DR severity per modified Davis staging · NIDEK AFC-230 · 45° FOV: 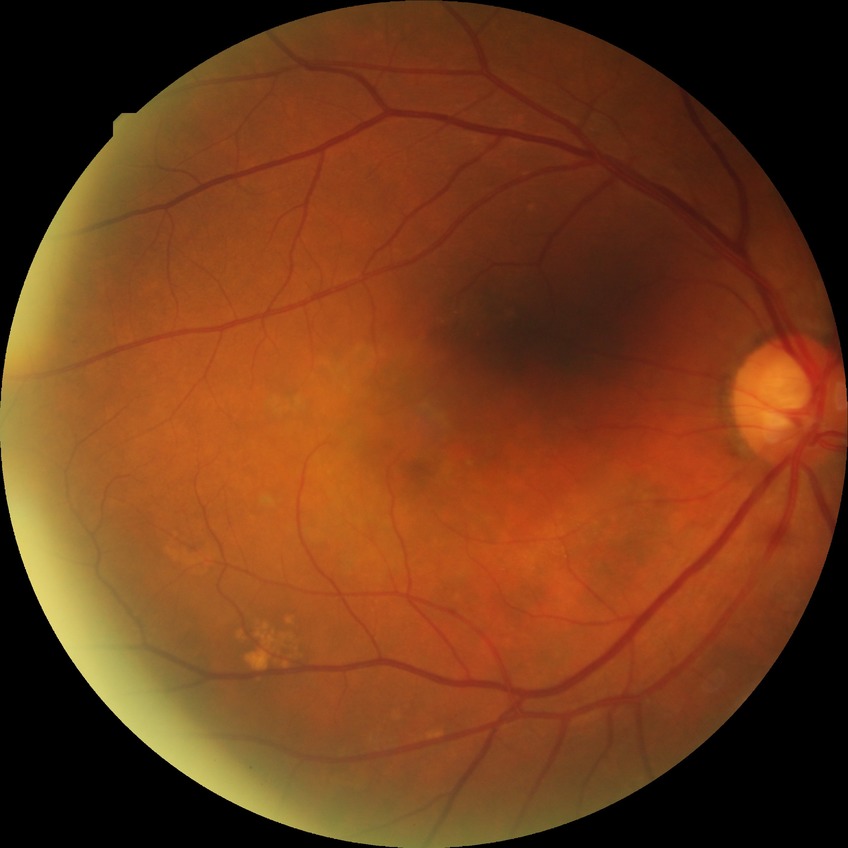
Modified Davis grading: no diabetic retinopathy.